Wide-field fundus photograph from neonatal ROP screening:
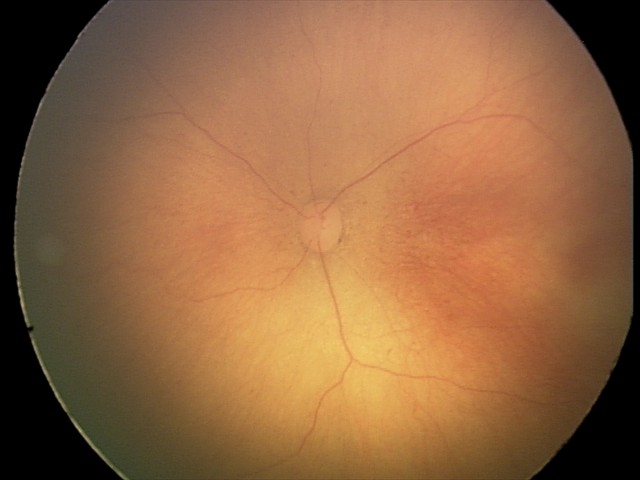 Plus disease: absent | diagnosis: retinopathy of prematurity (ROP) stage 0.